Color fundus image; 45° field of view
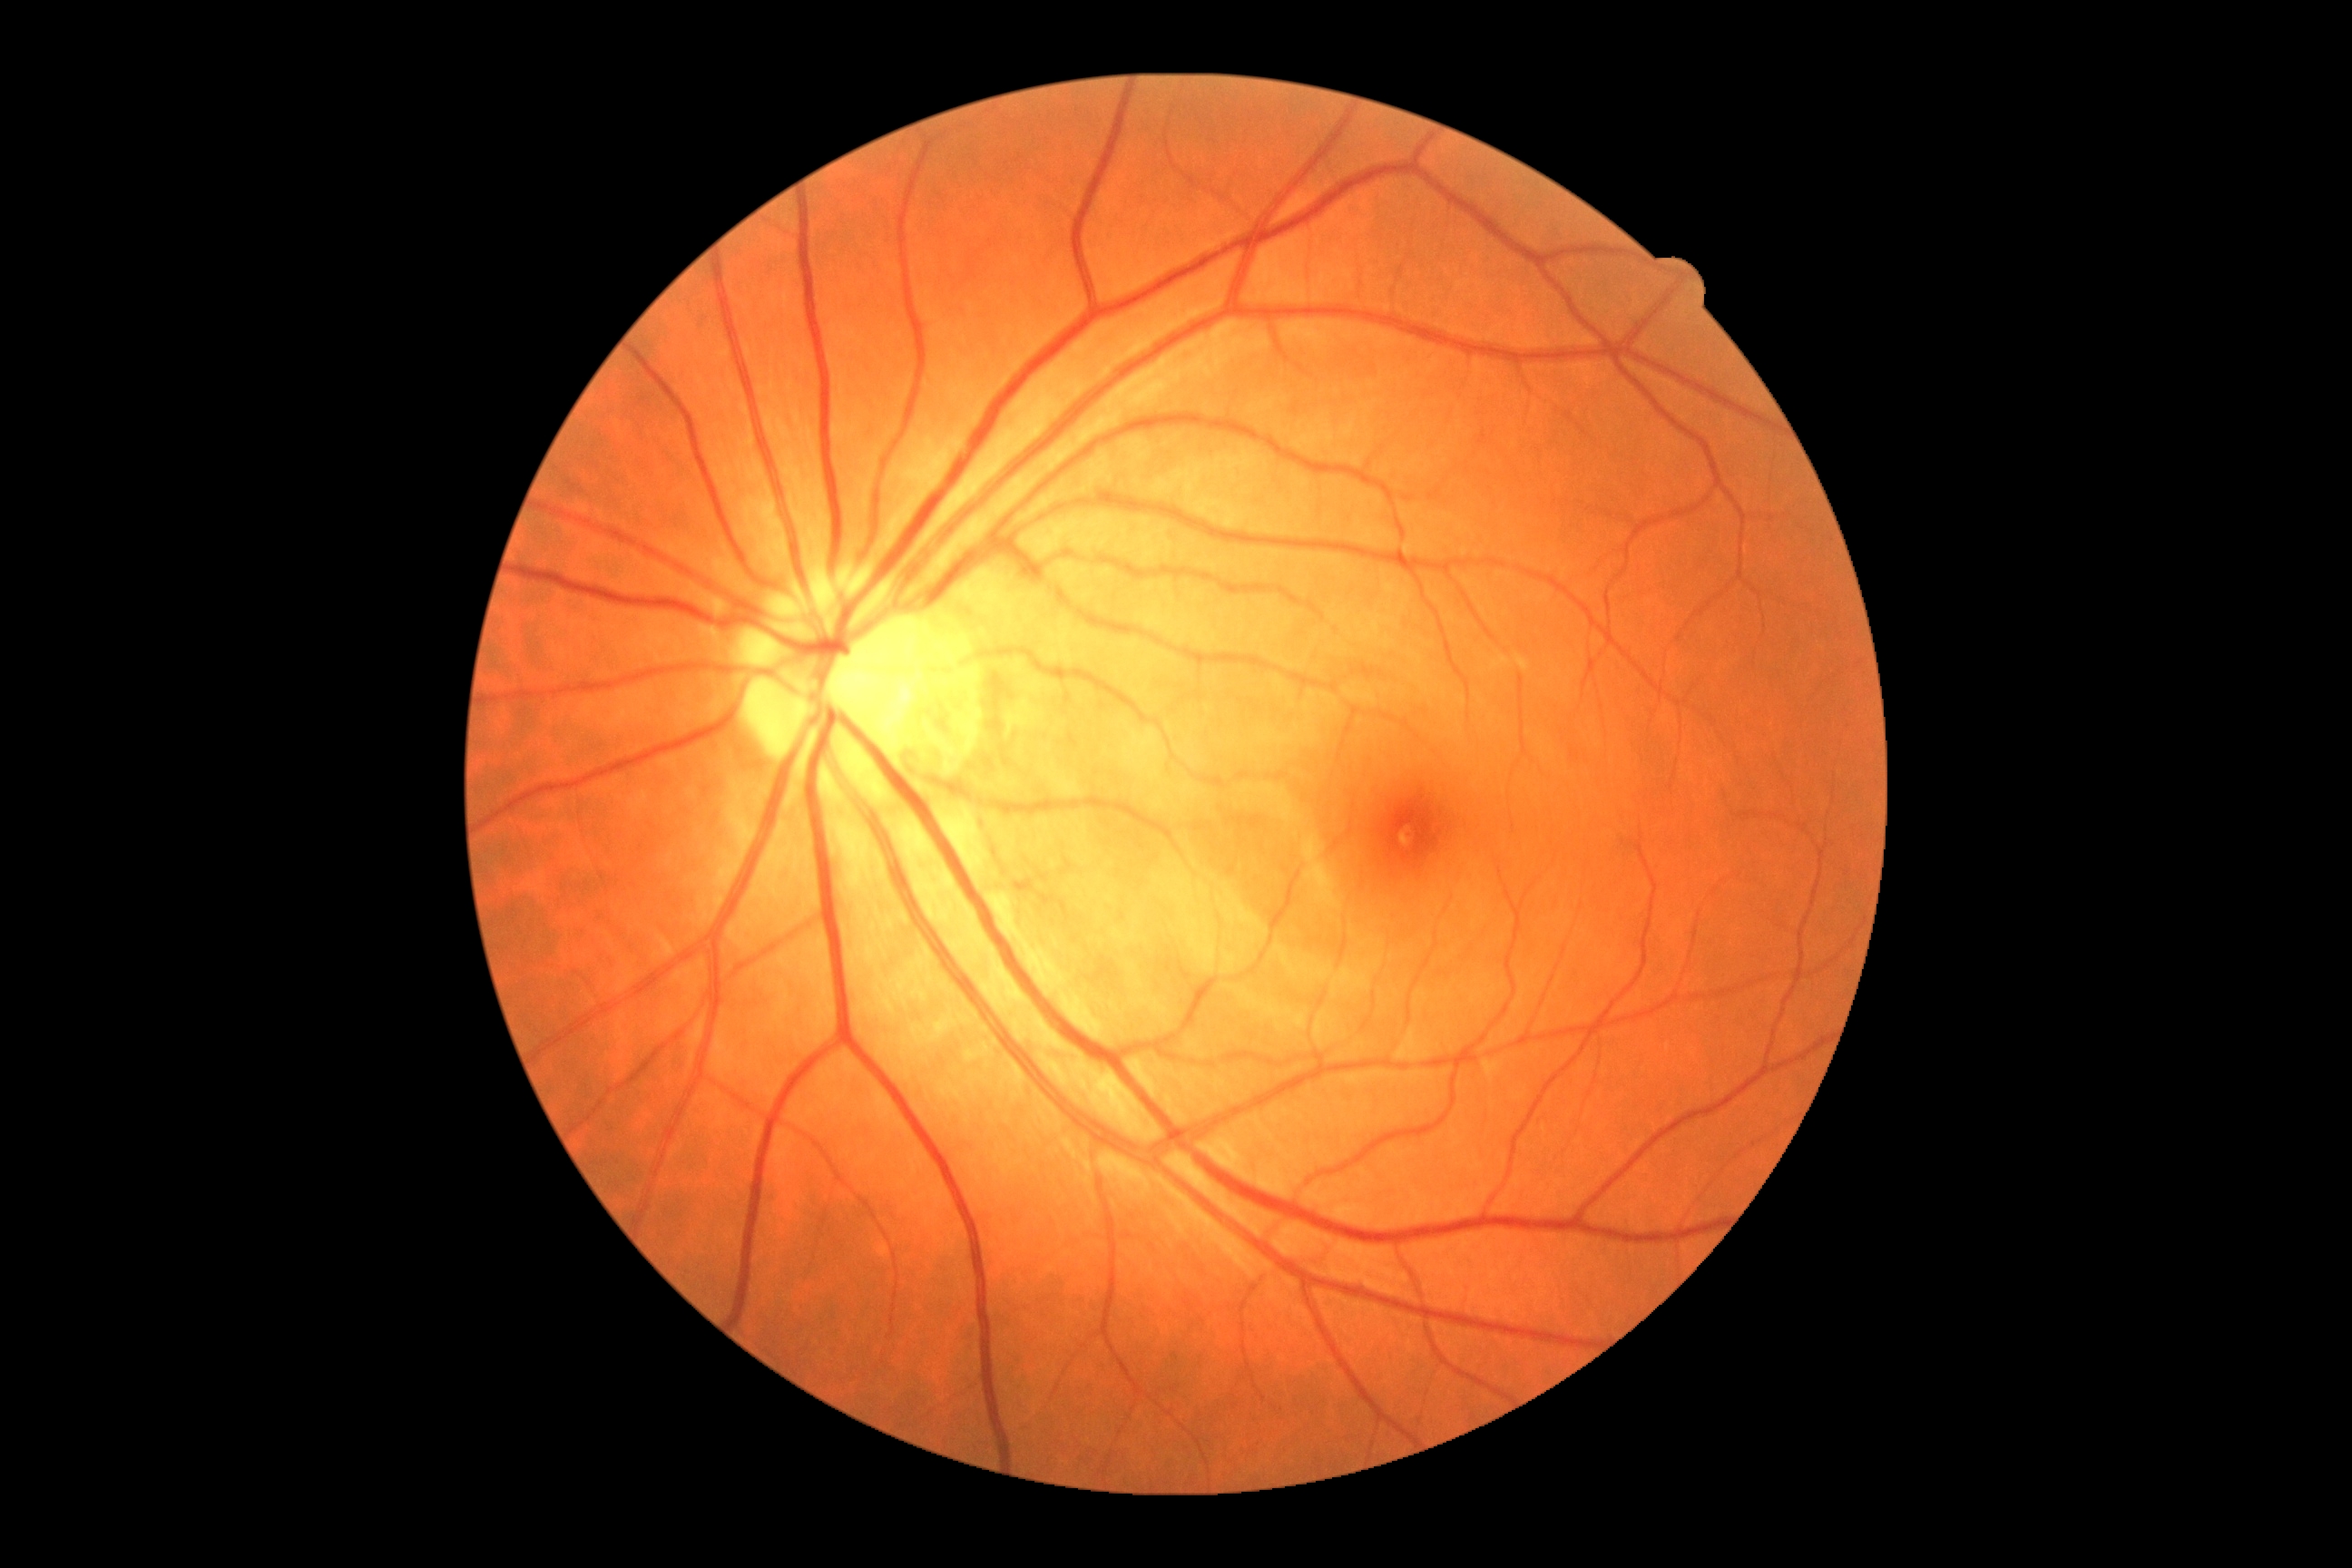
Retinopathy is grade 0 (no apparent retinopathy).